Modified Davis classification
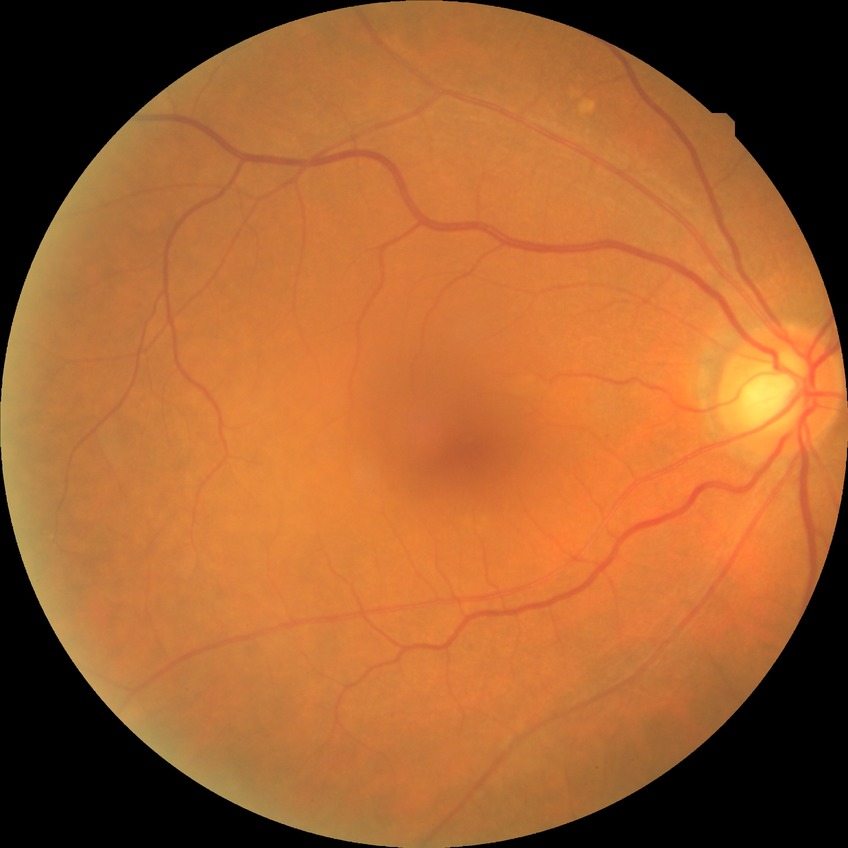

Diabetic retinopathy (DR): no diabetic retinopathy (NDR).